45-degree field of view, color fundus image, 1725 x 1721 pixels: 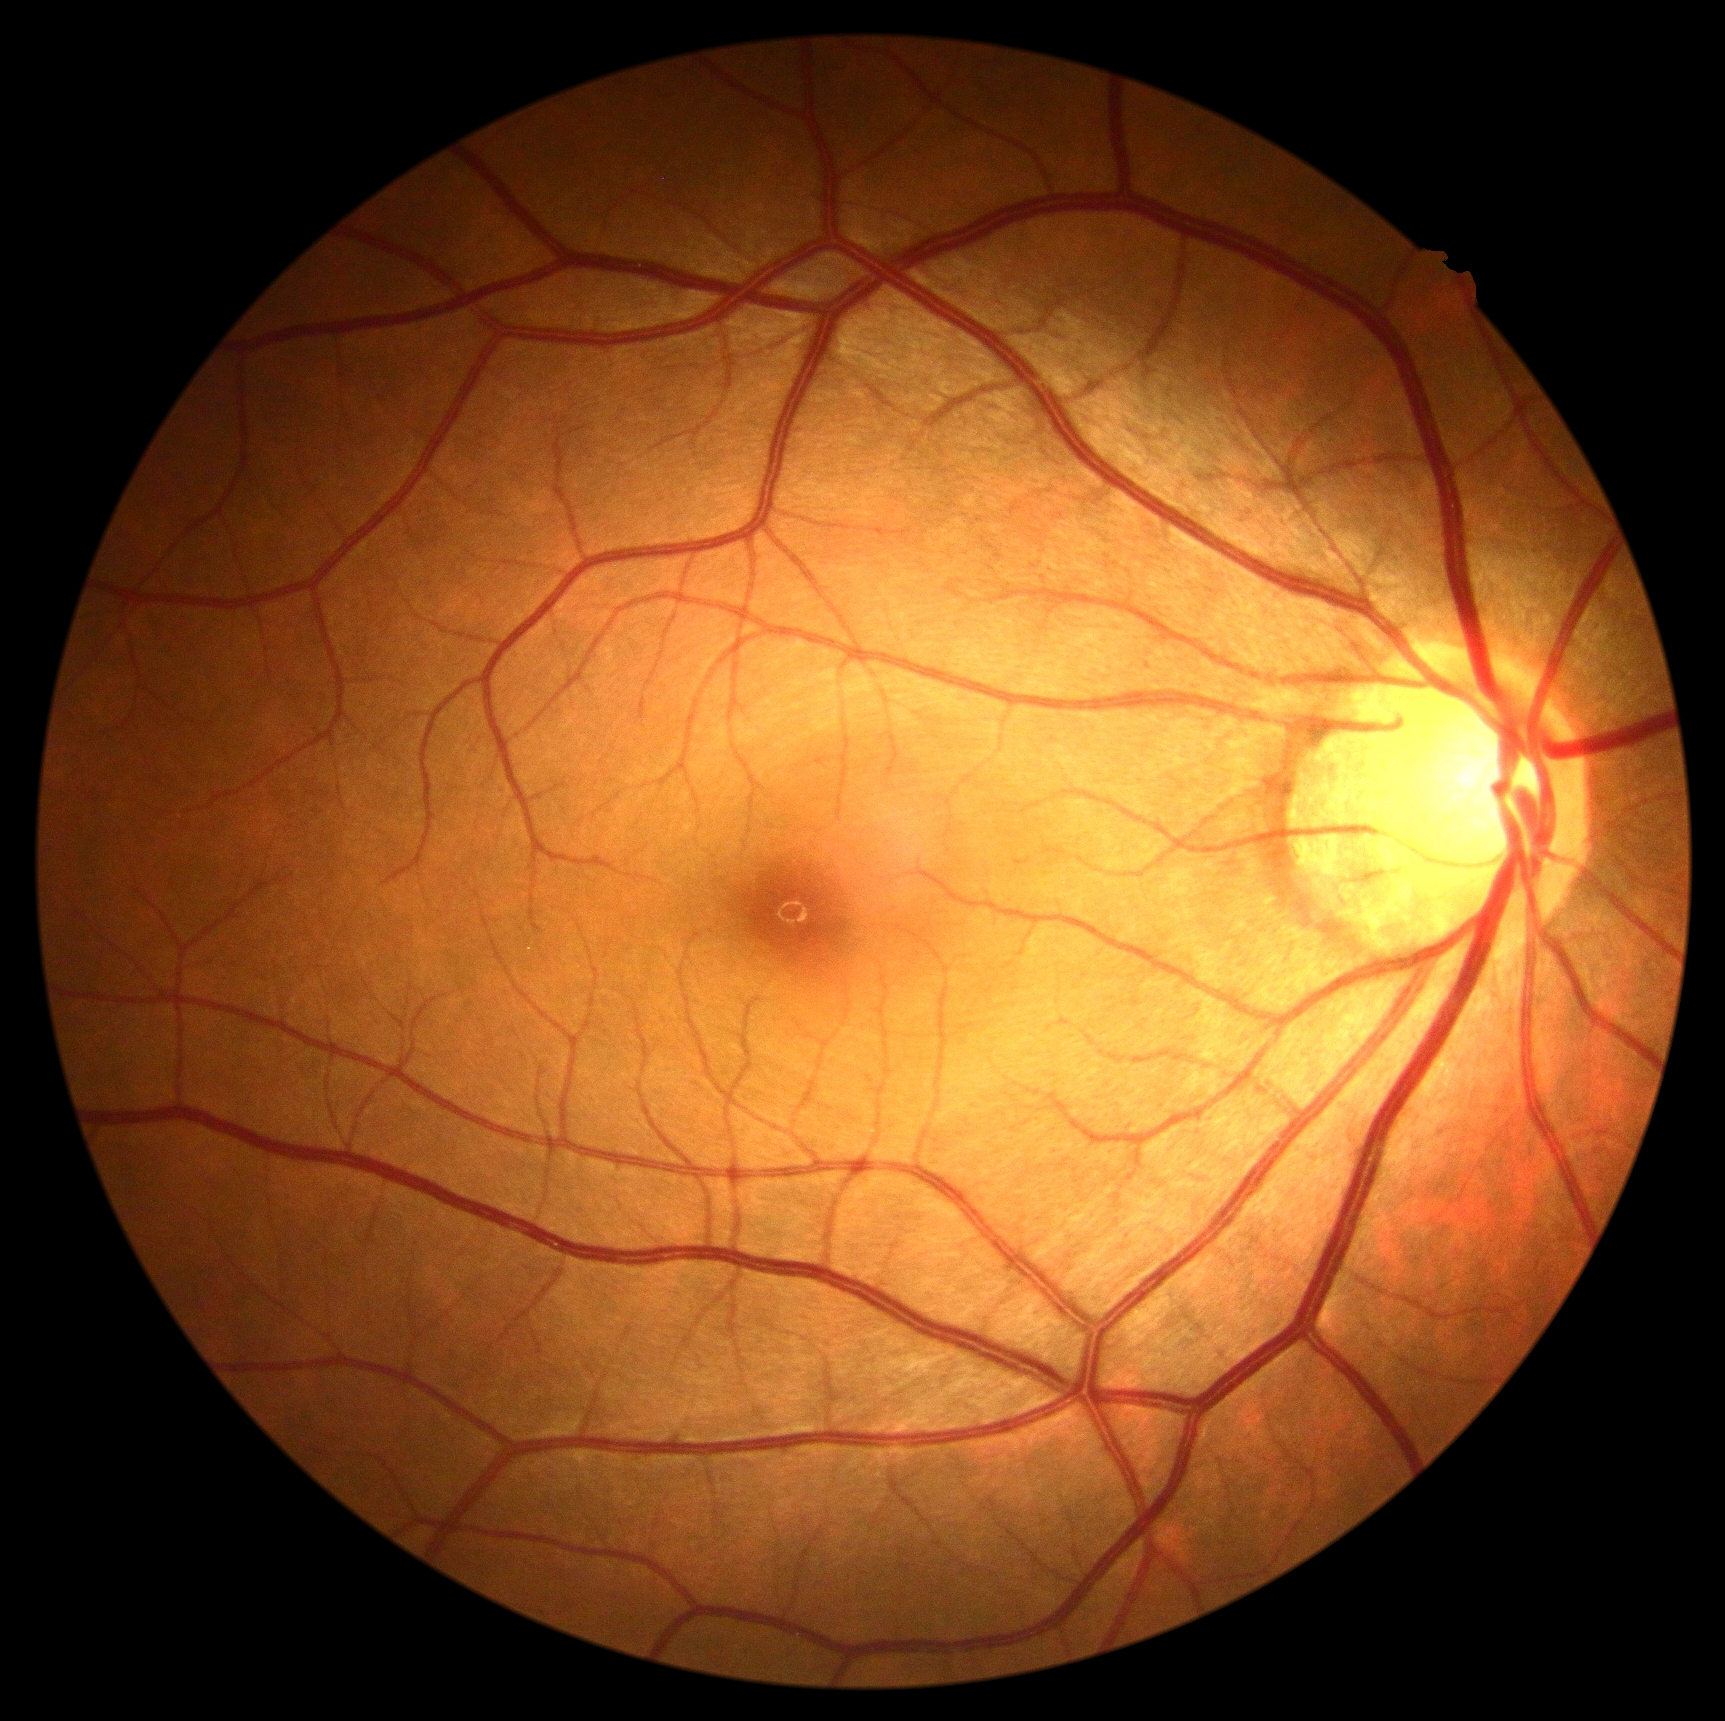
Retinopathy: 0.
No DR findings.